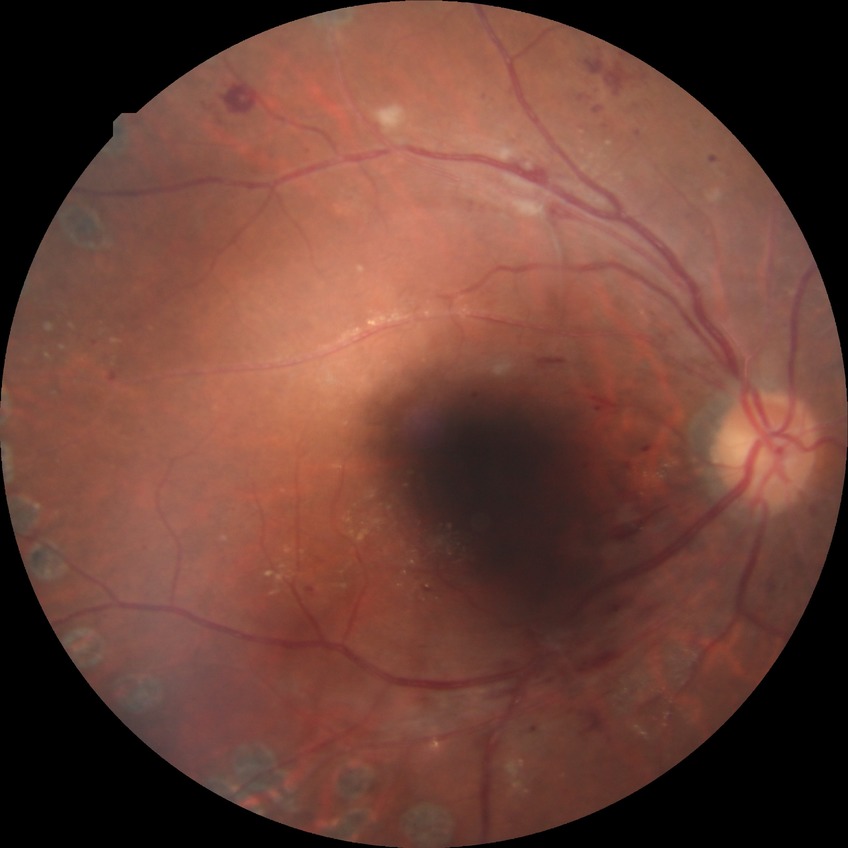

Diabetic retinopathy severity is proliferative diabetic retinopathy.